848 by 848 pixels:
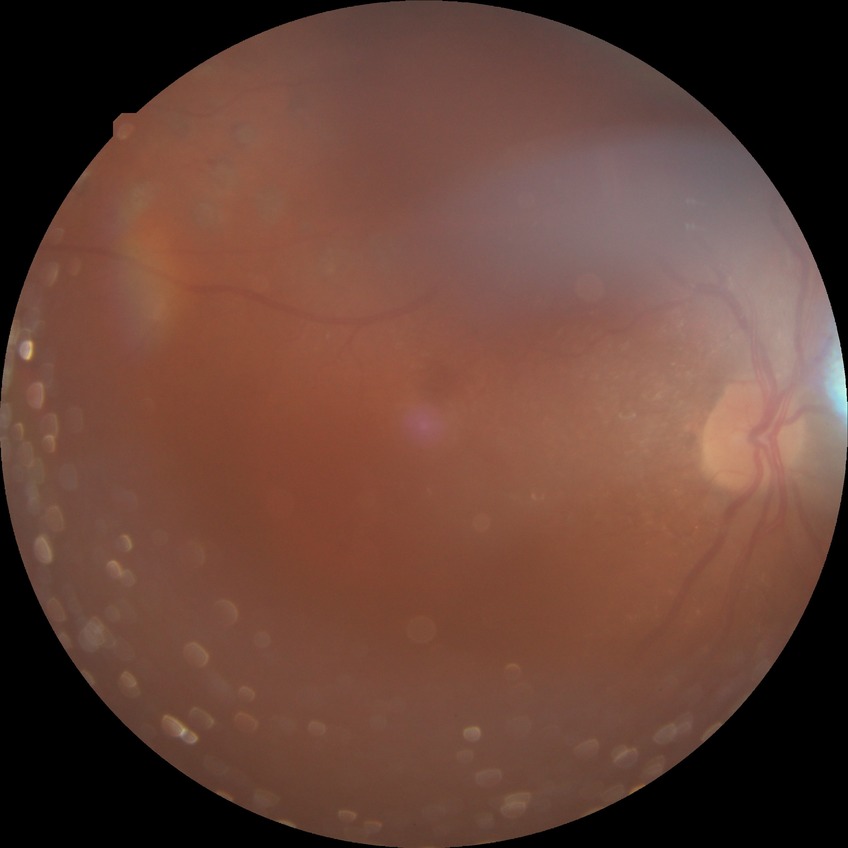 Modified Davis grading is proliferative diabetic retinopathy.